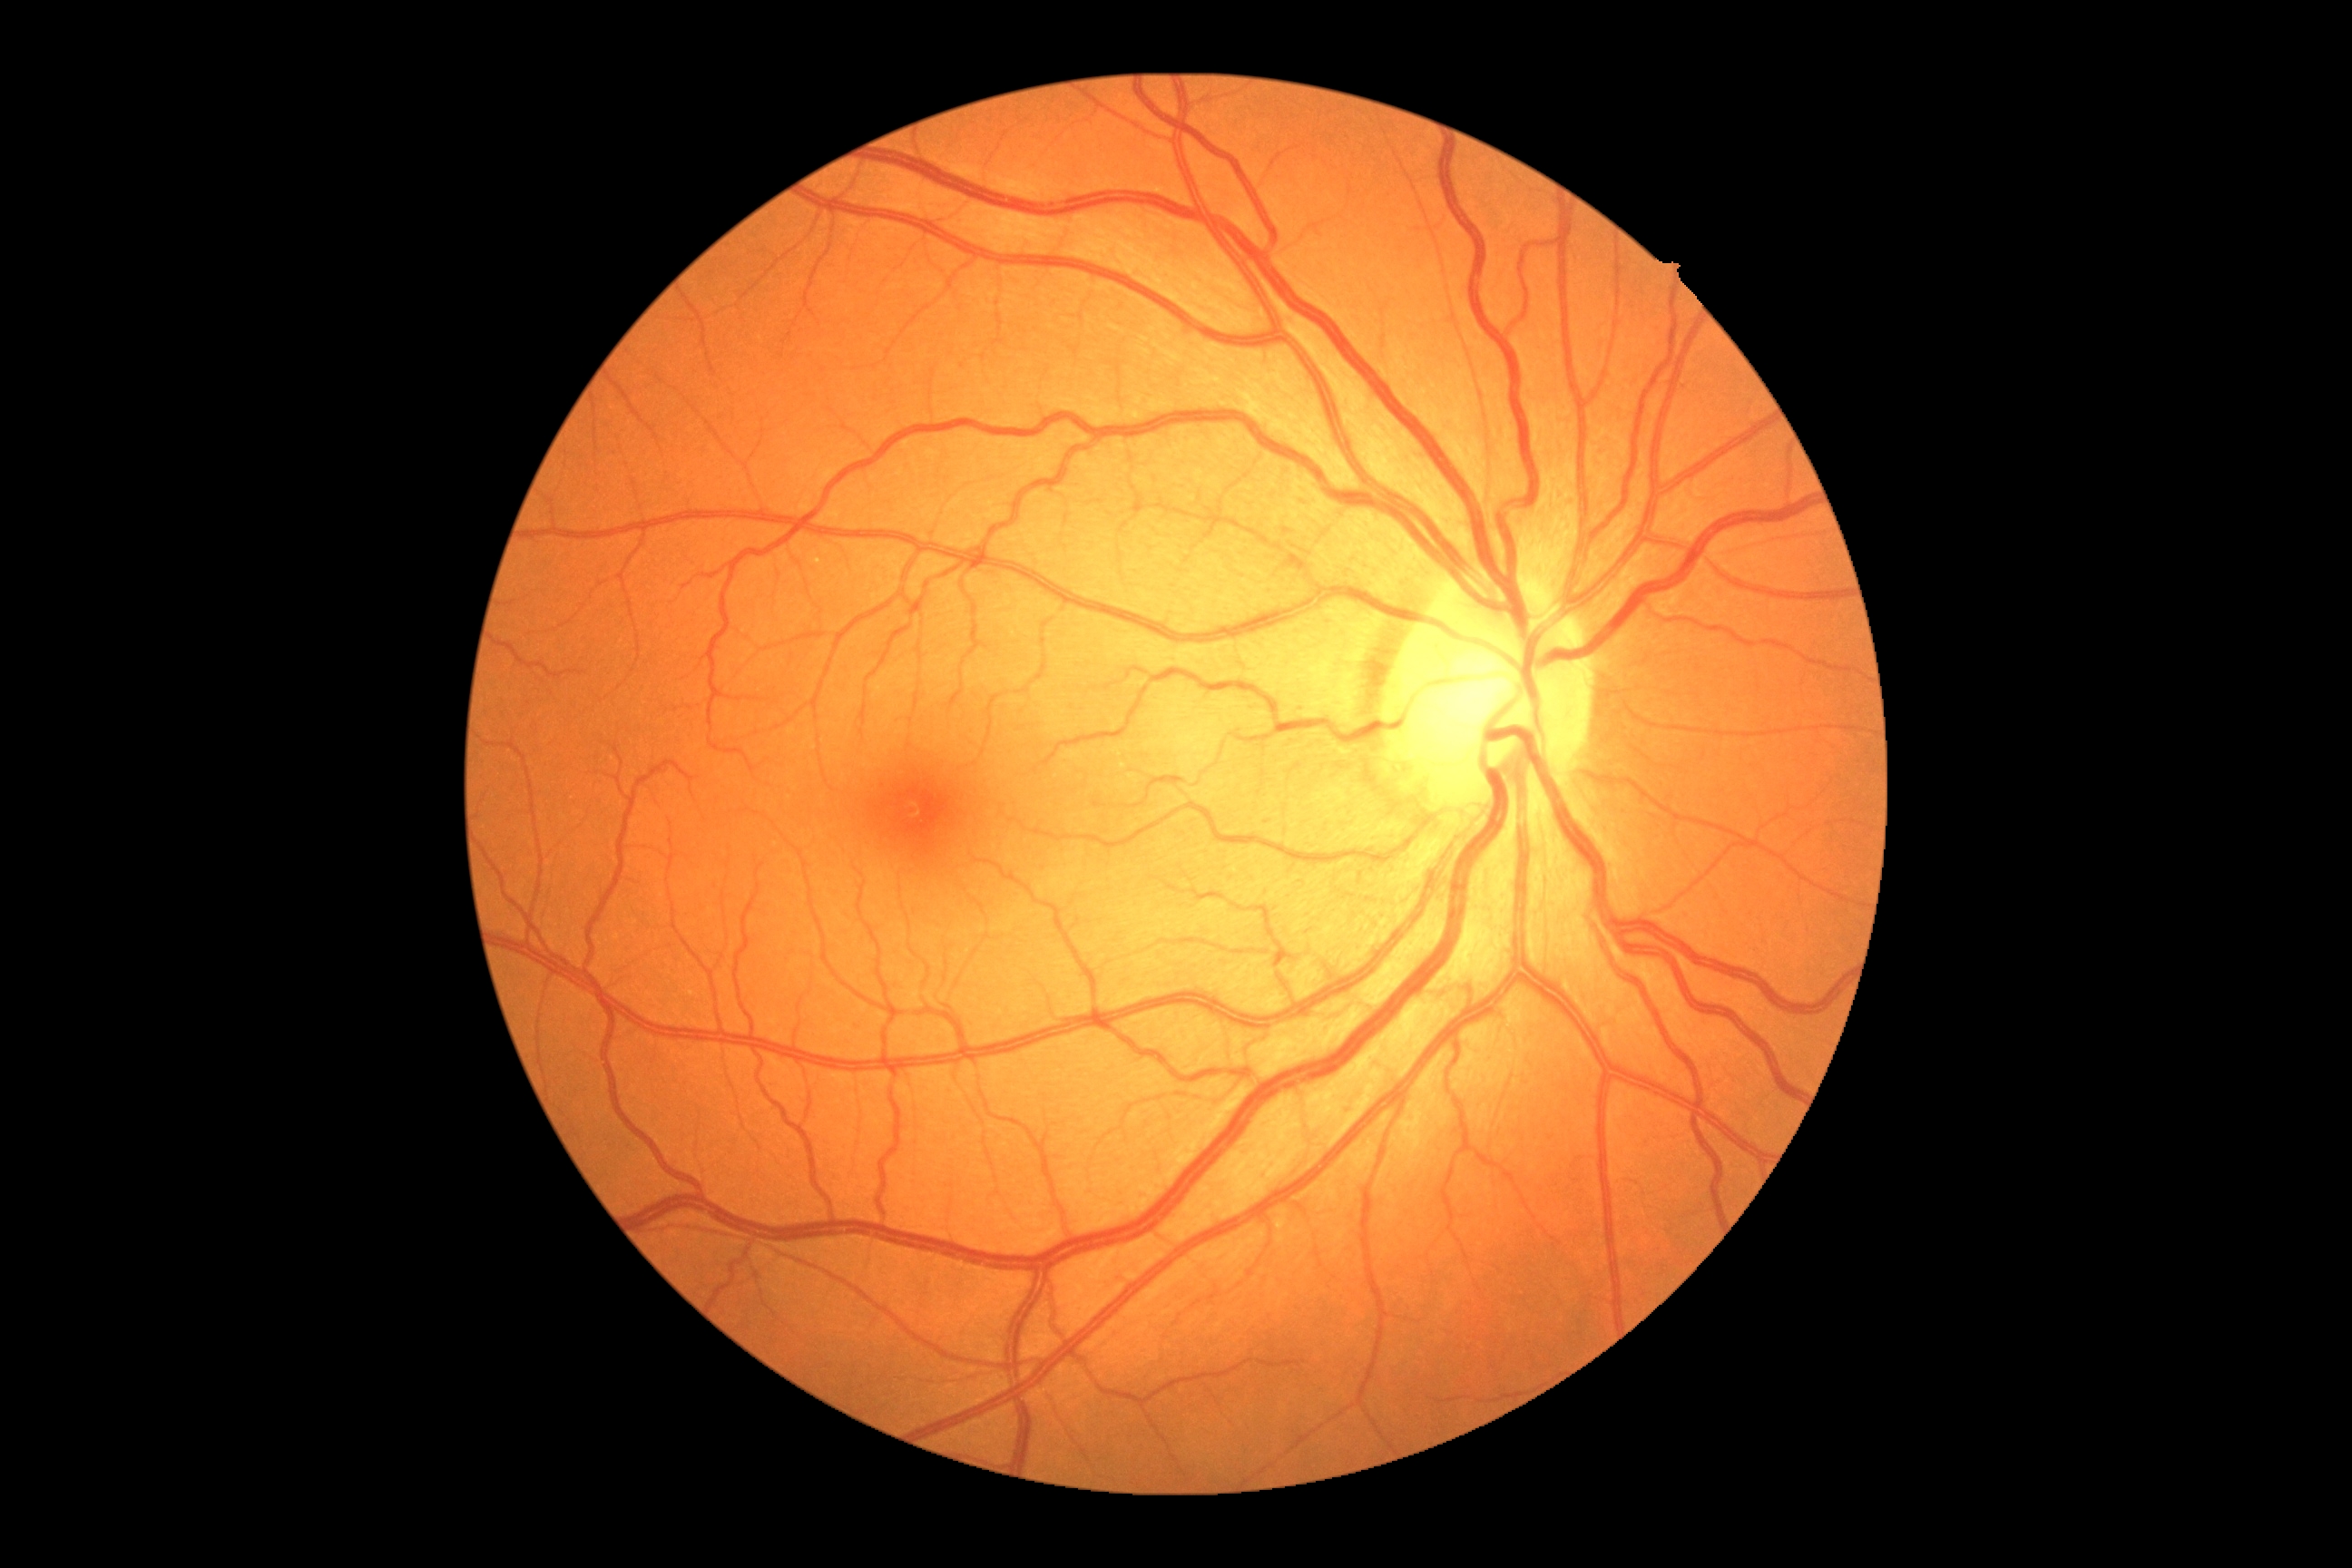 Retinopathy grade is 0. No signs of diabetic retinopathy.